45° FOV
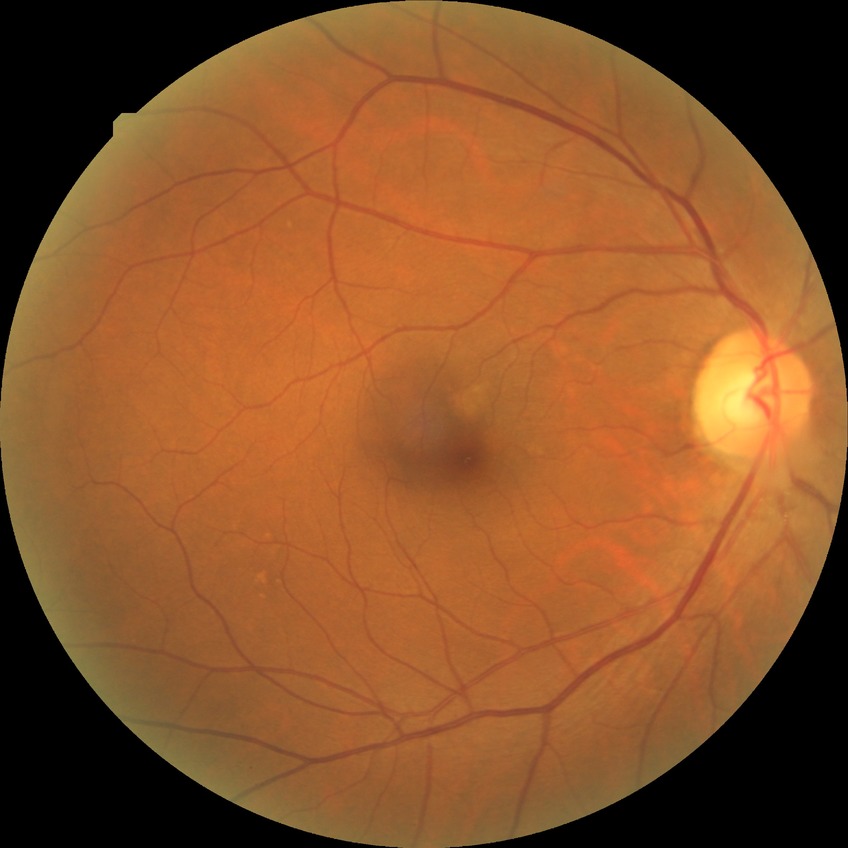
Diabetic retinopathy grade is no diabetic retinopathy.